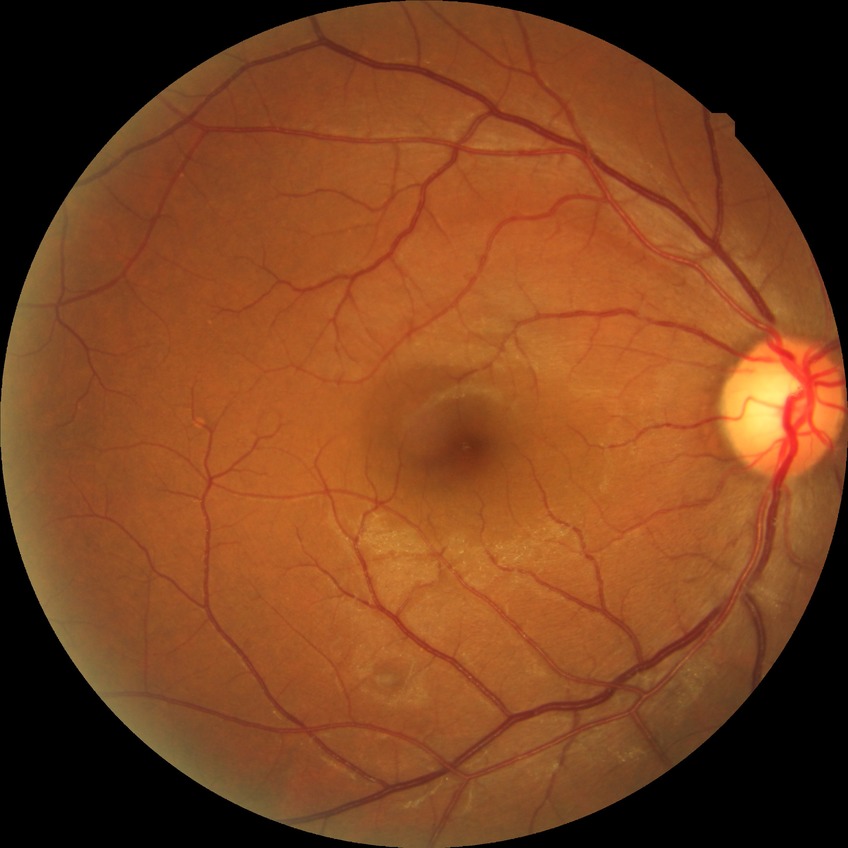
  davis_grade: no diabetic retinopathy